Infant wide-field fundus photograph
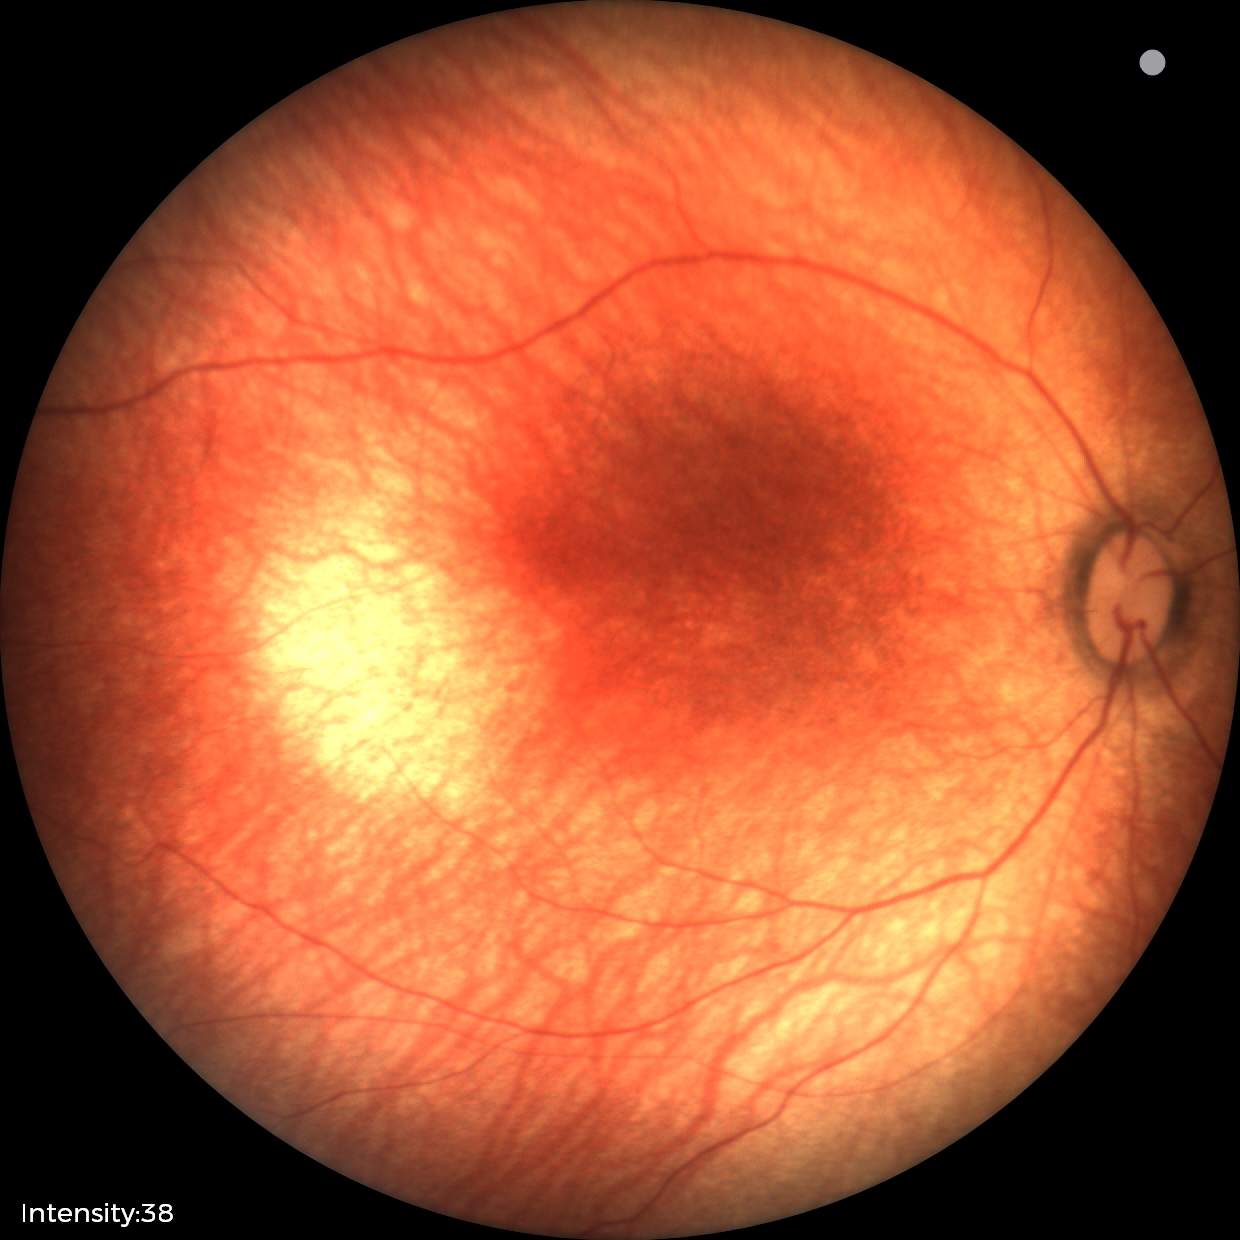 Q: What is the diagnosis from this examination?
A: normal fundus examination